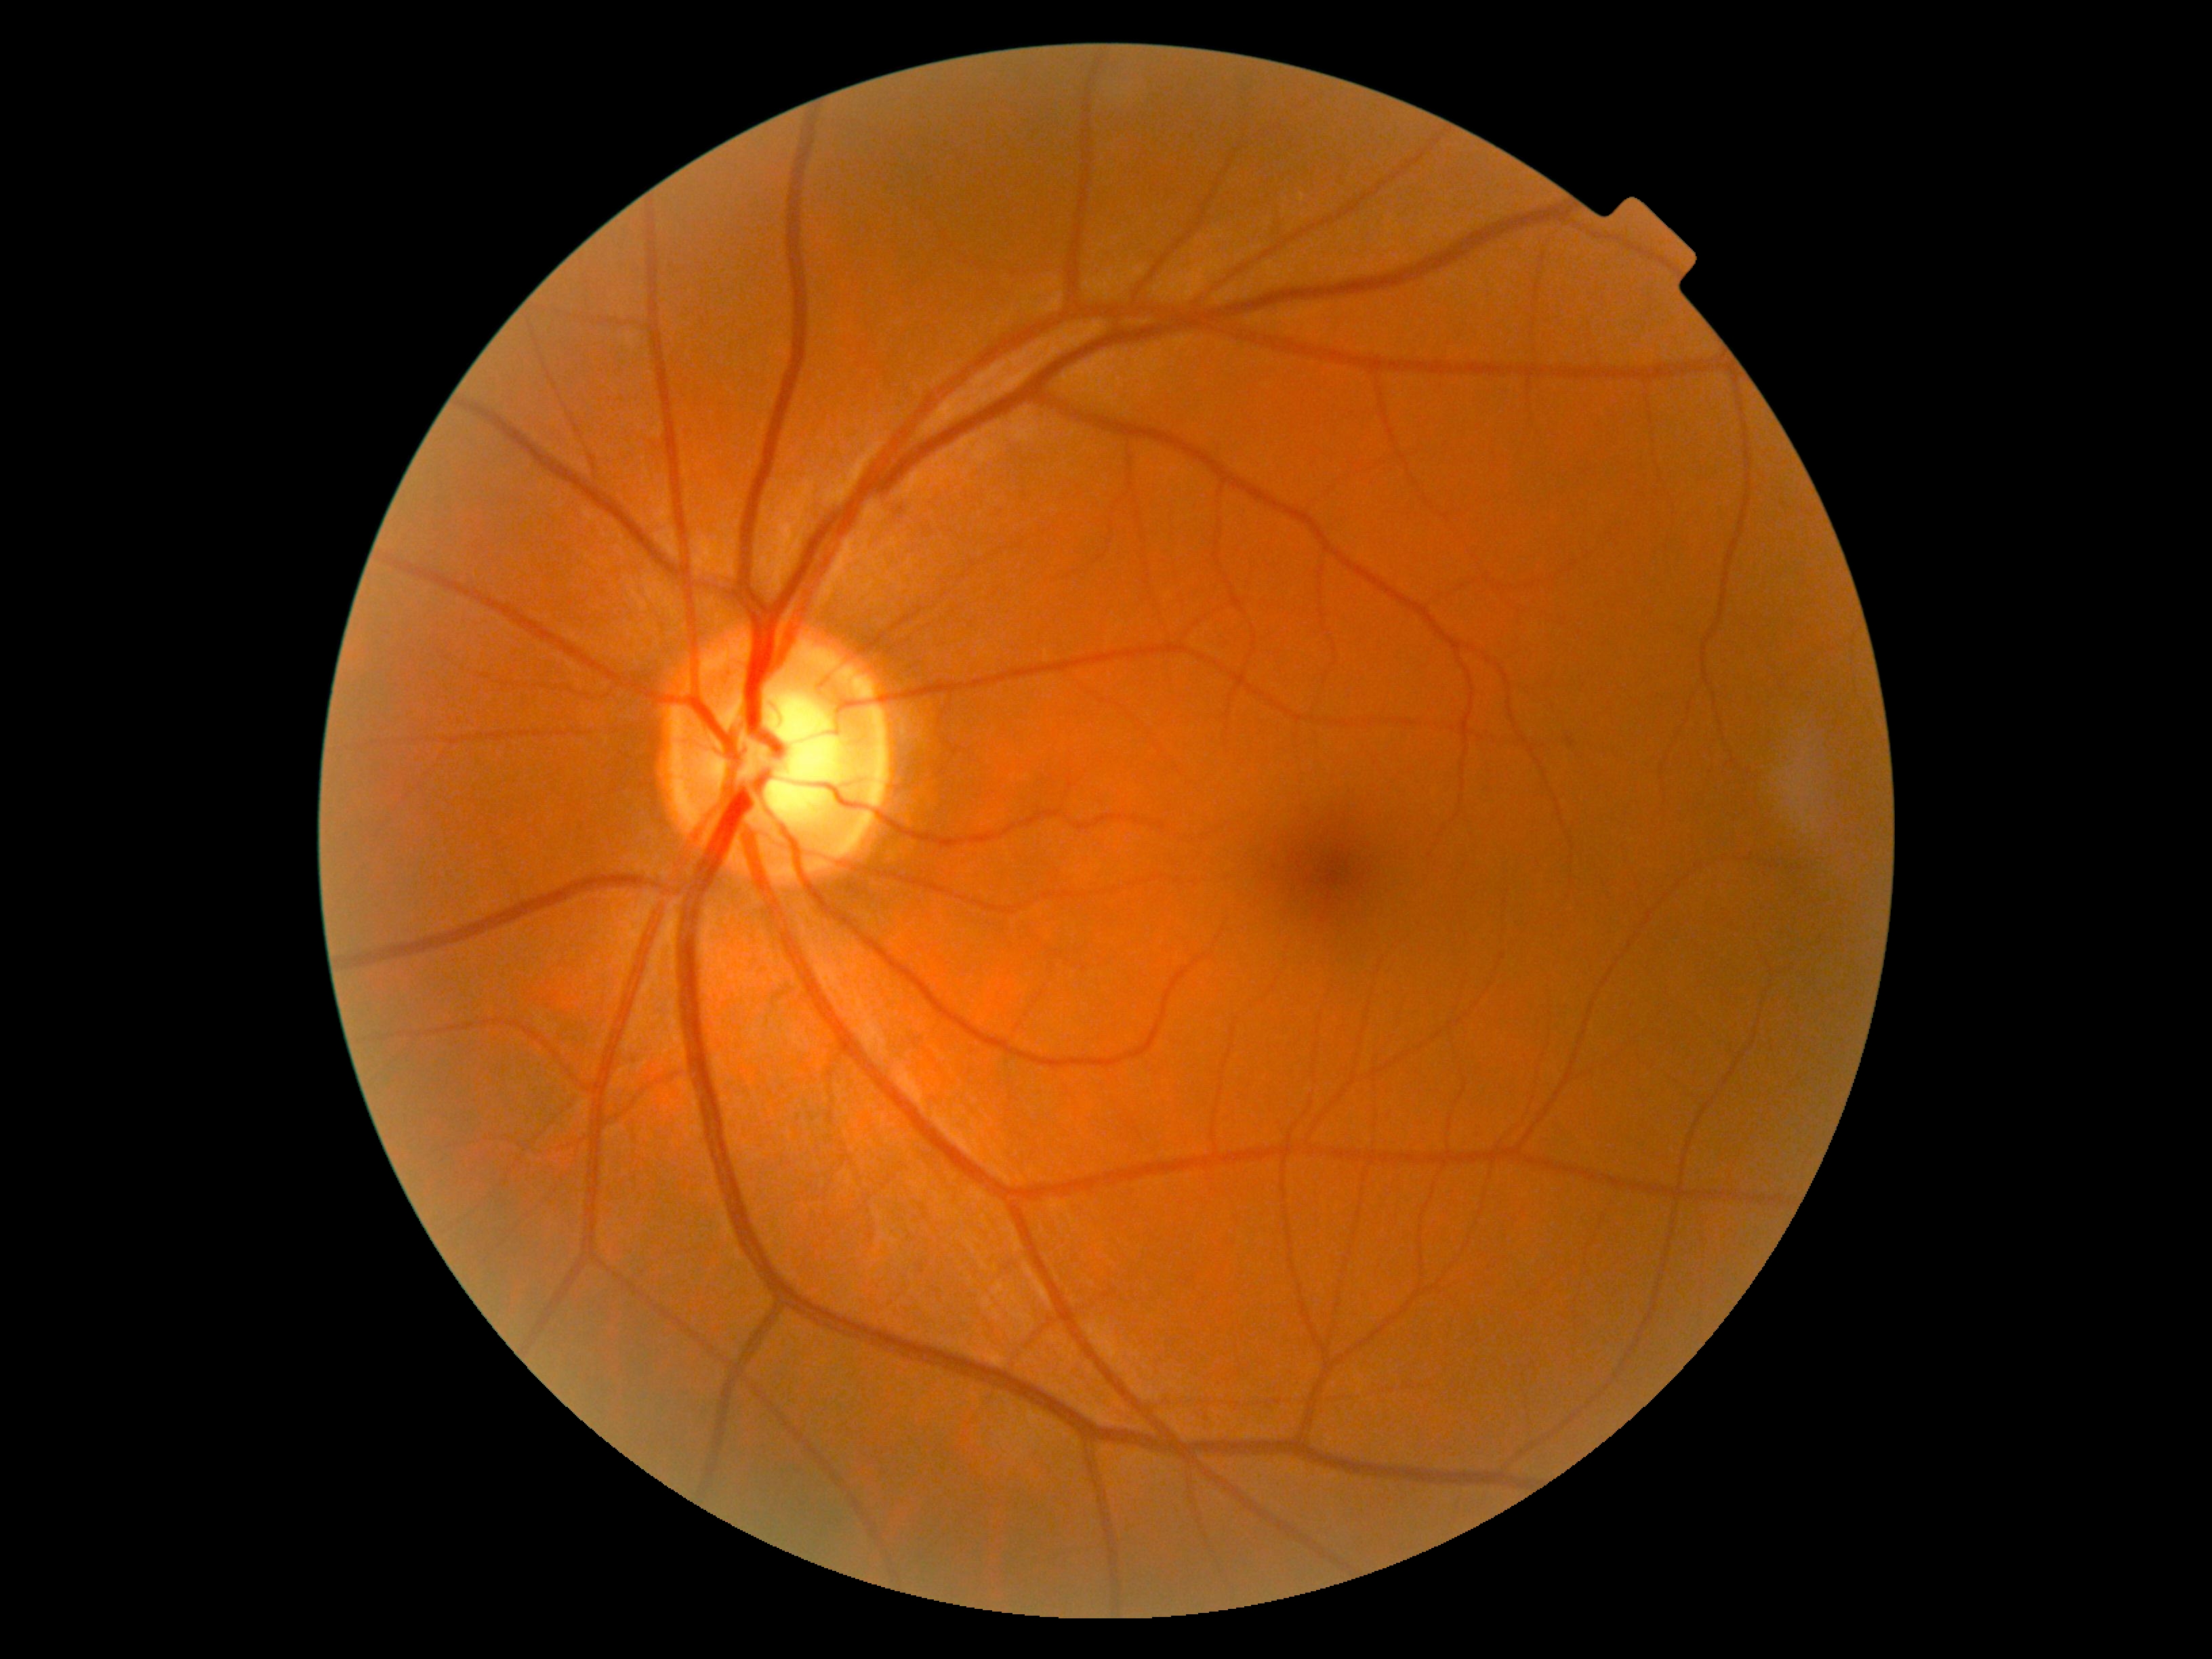

Findings:
- DR severity — grade 0